Color fundus image:
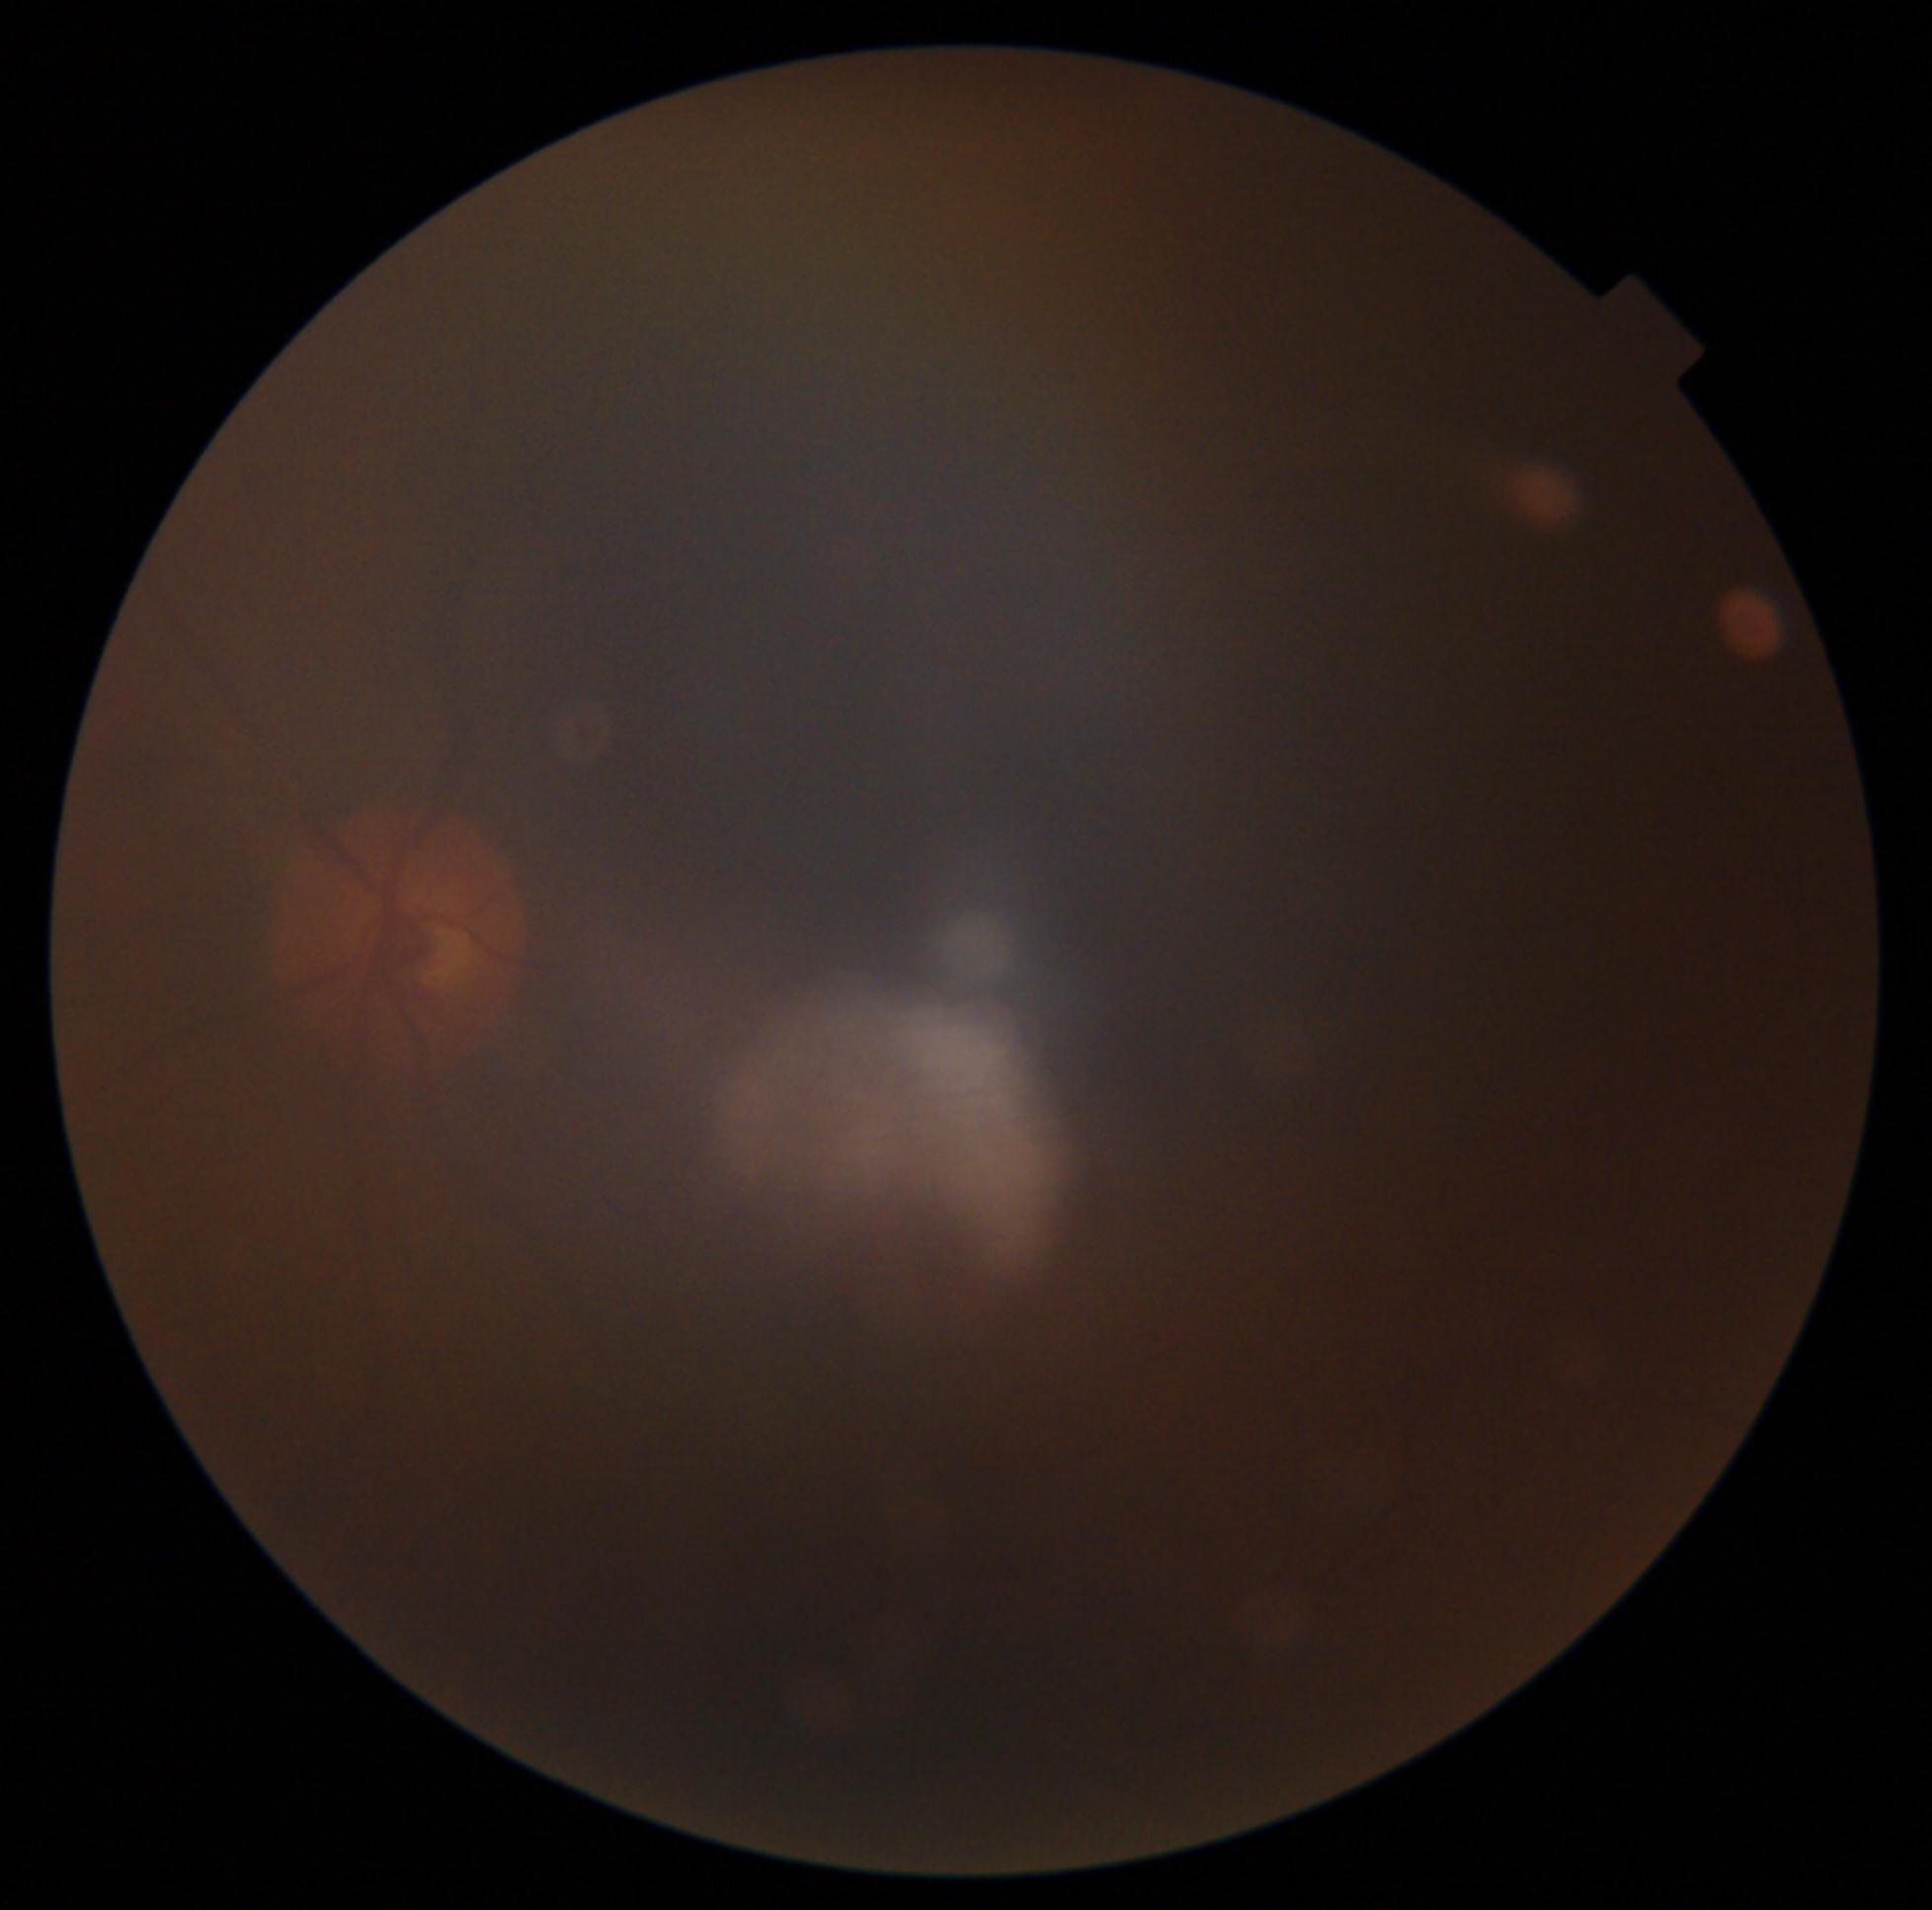 dr_grade: ungradable due to poor image quality
quality: too poor for DR grading